Retinal fundus photograph. Modified Davis grading: 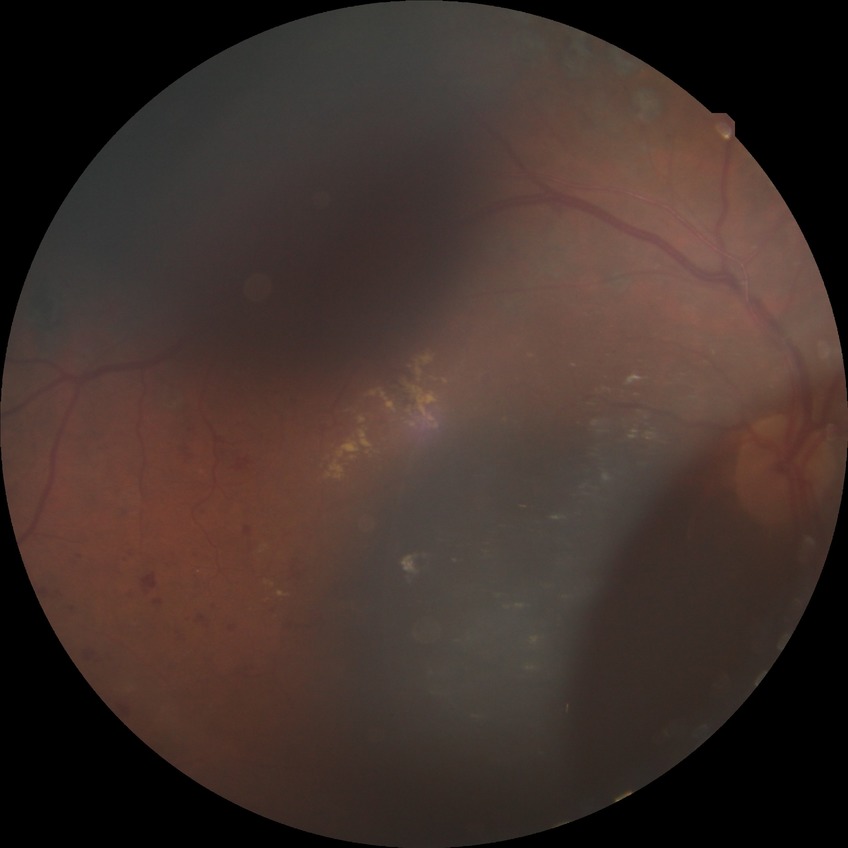 Diabetic retinopathy (DR): proliferative diabetic retinopathy (PDR).